Modified Davis classification. 848 by 848 pixels. 45-degree field of view — 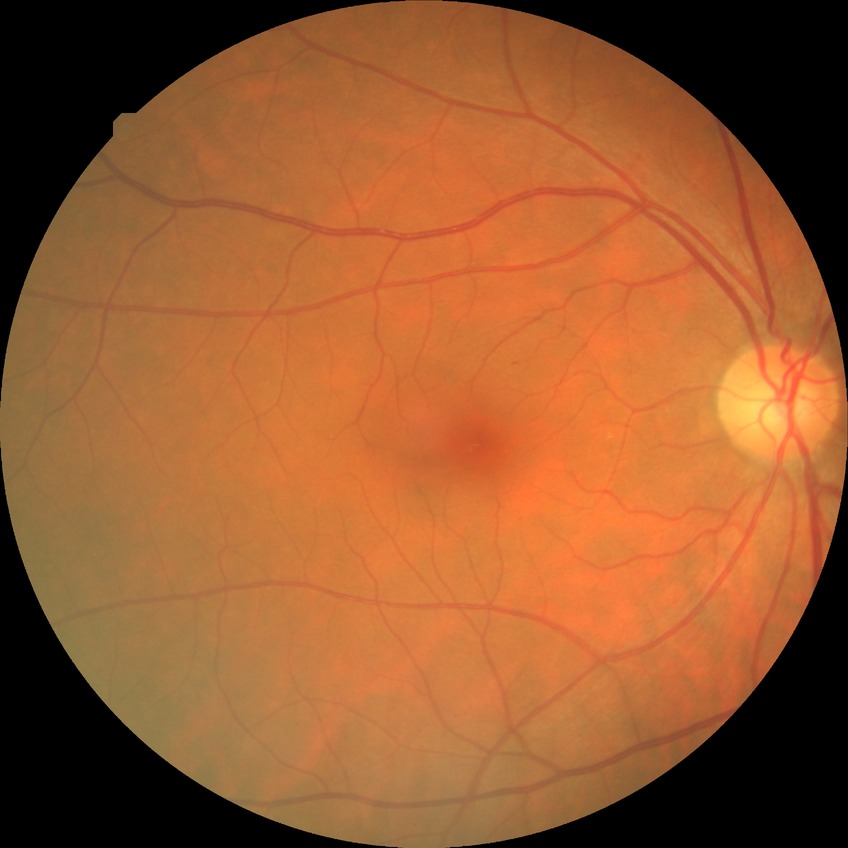

davis_grade: no diabetic retinopathy (NDR)